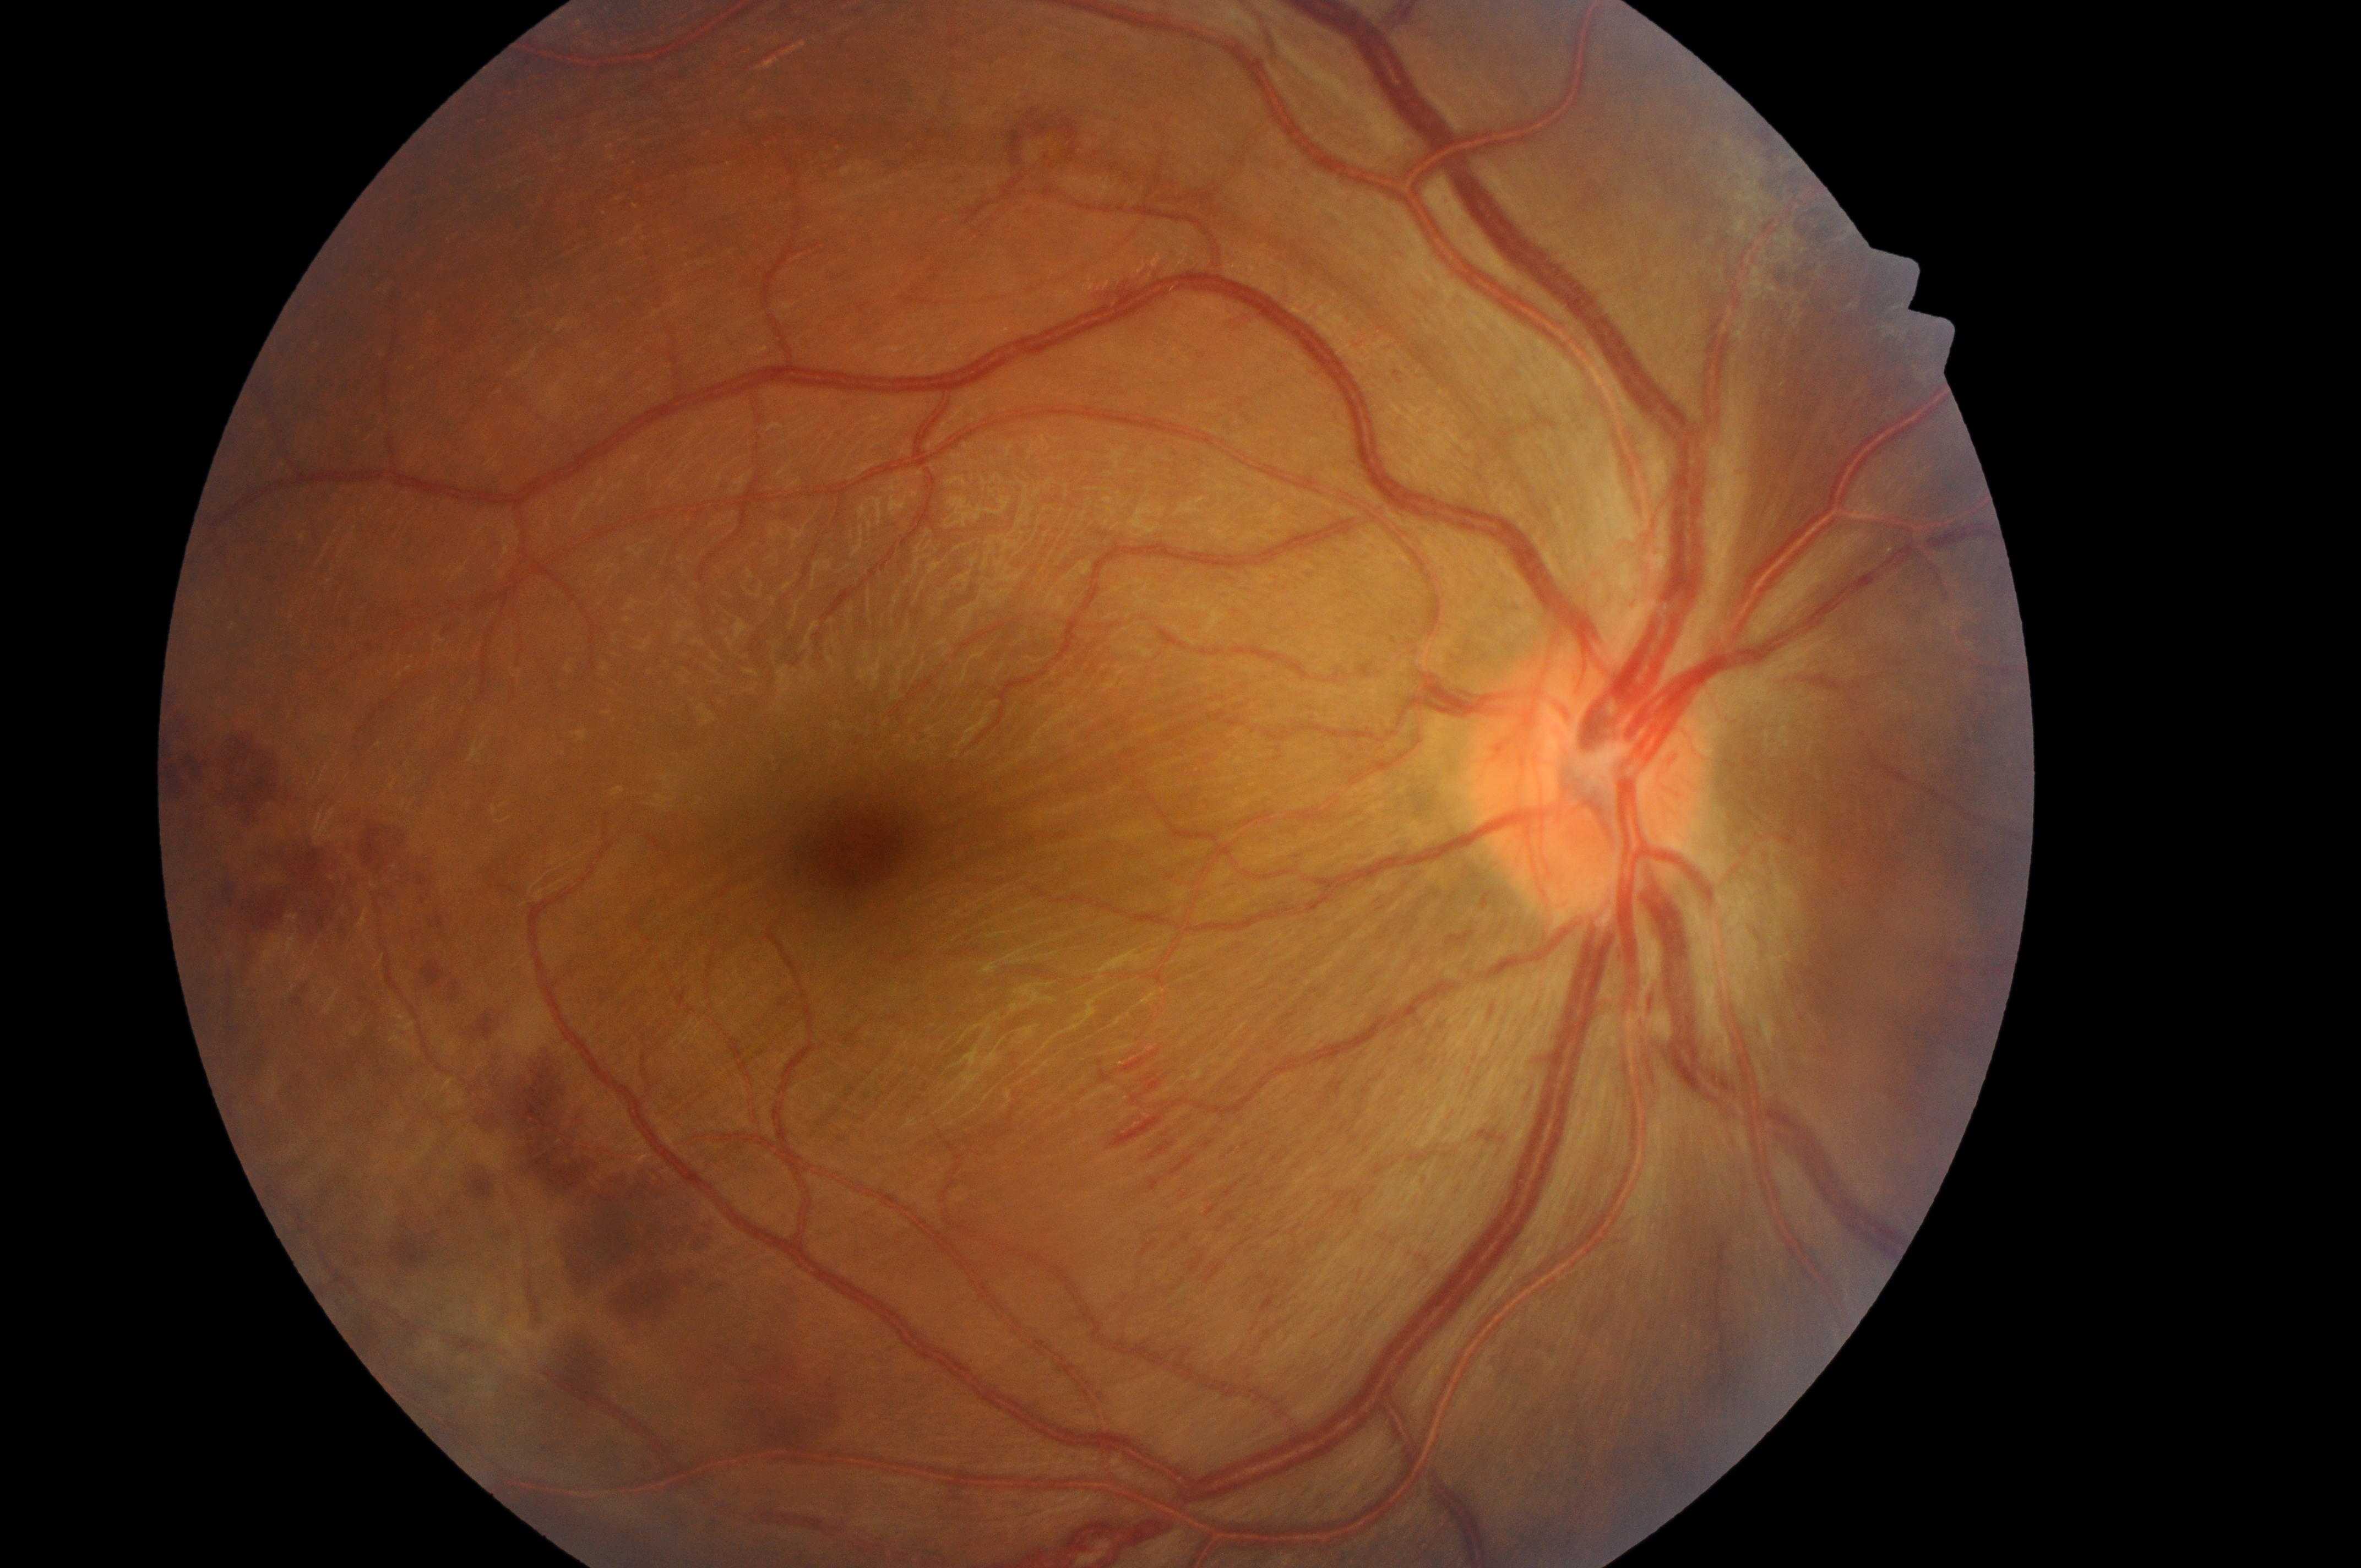

- DR: proliferative diabetic retinopathy (grade 4)
- DME grade: 0 (no risk)
- laterality: the right eye
- optic disk: (1586,787)
- fovea center: (860,853)